Fundus photo:
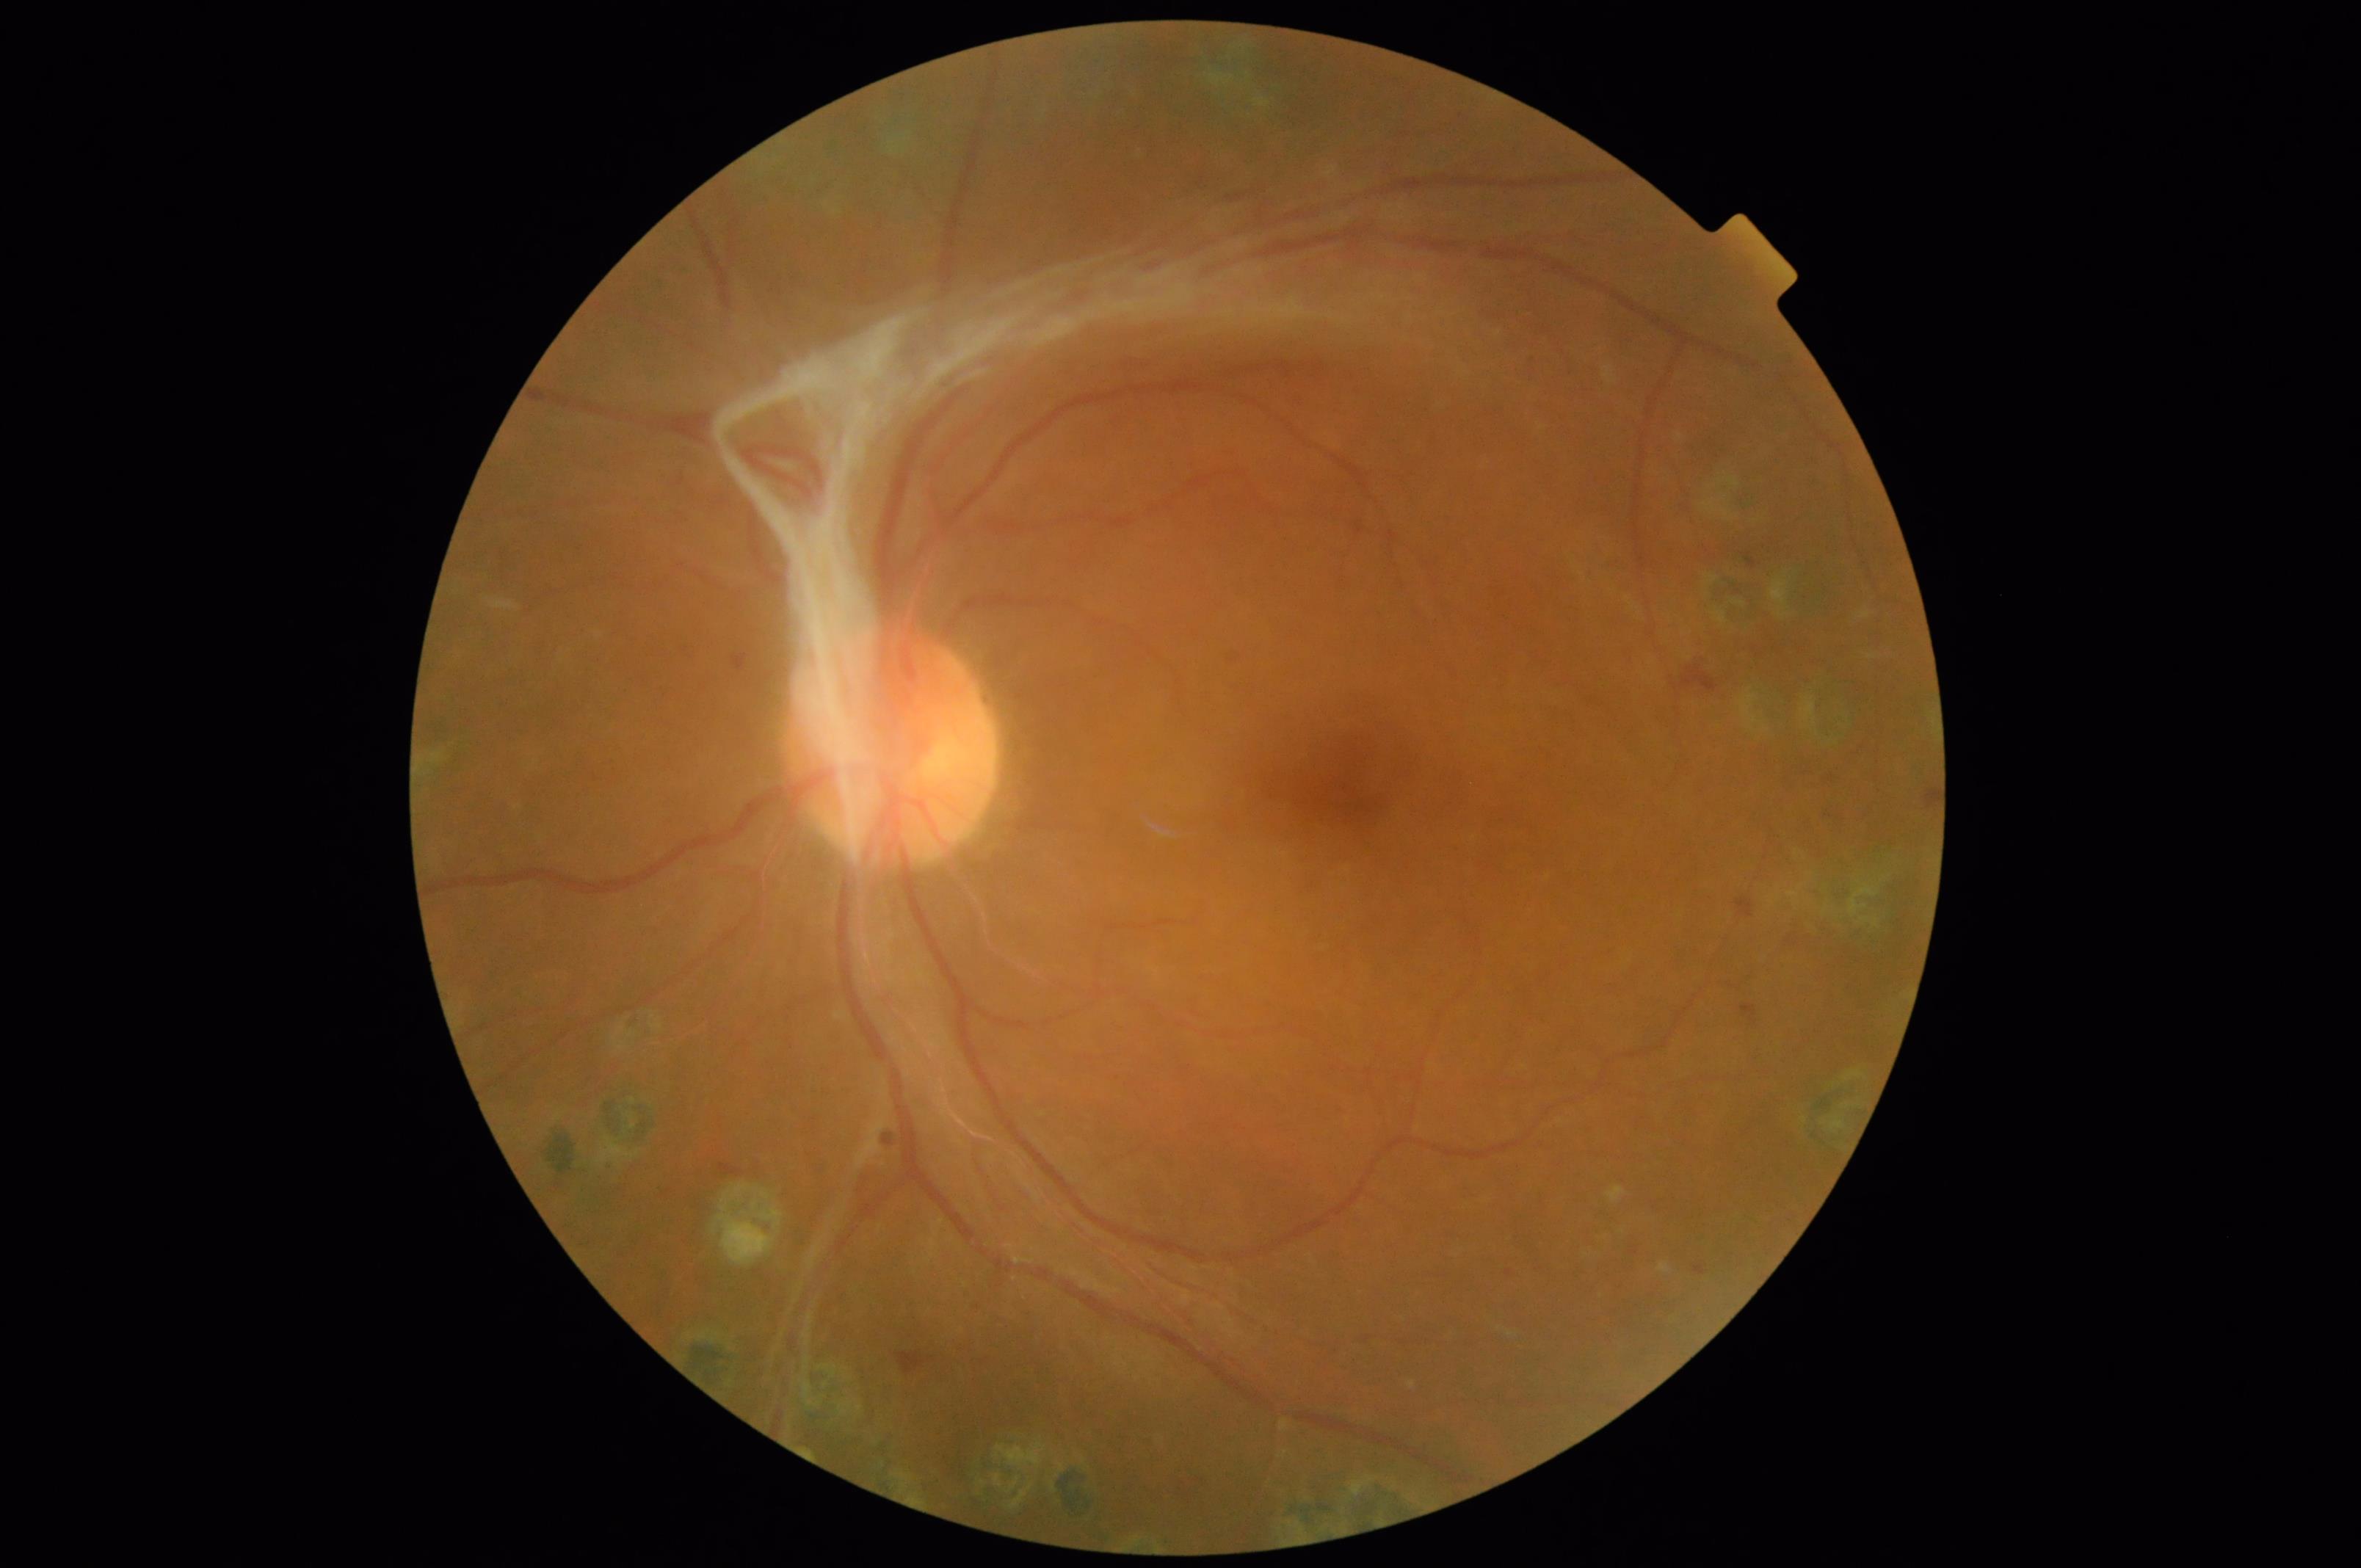 No noticeable blur. Illumination and color balance are good. Overall quality is good and the image is gradable. Vessels and details are readily distinguishable.